No pharmacologic dilation · NIDEK AFC-230 fundus camera · modified Davis classification:
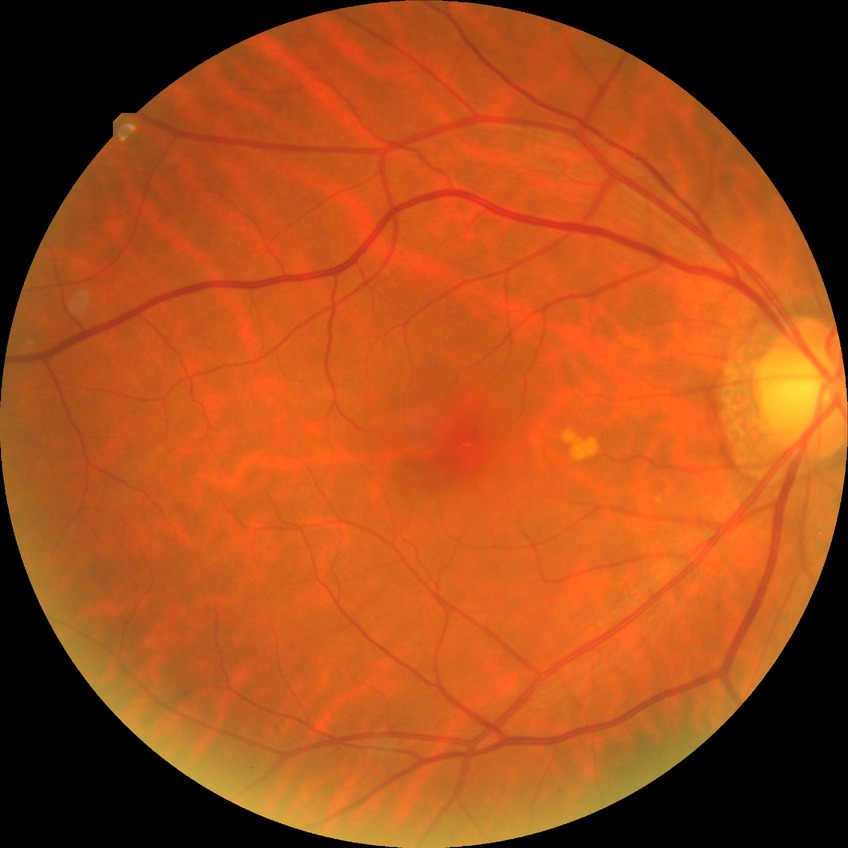

Assessment:
- diabetic retinopathy (DR): NDR (no diabetic retinopathy)